FOV: 45 degrees, image size 2184x1690, CFP — 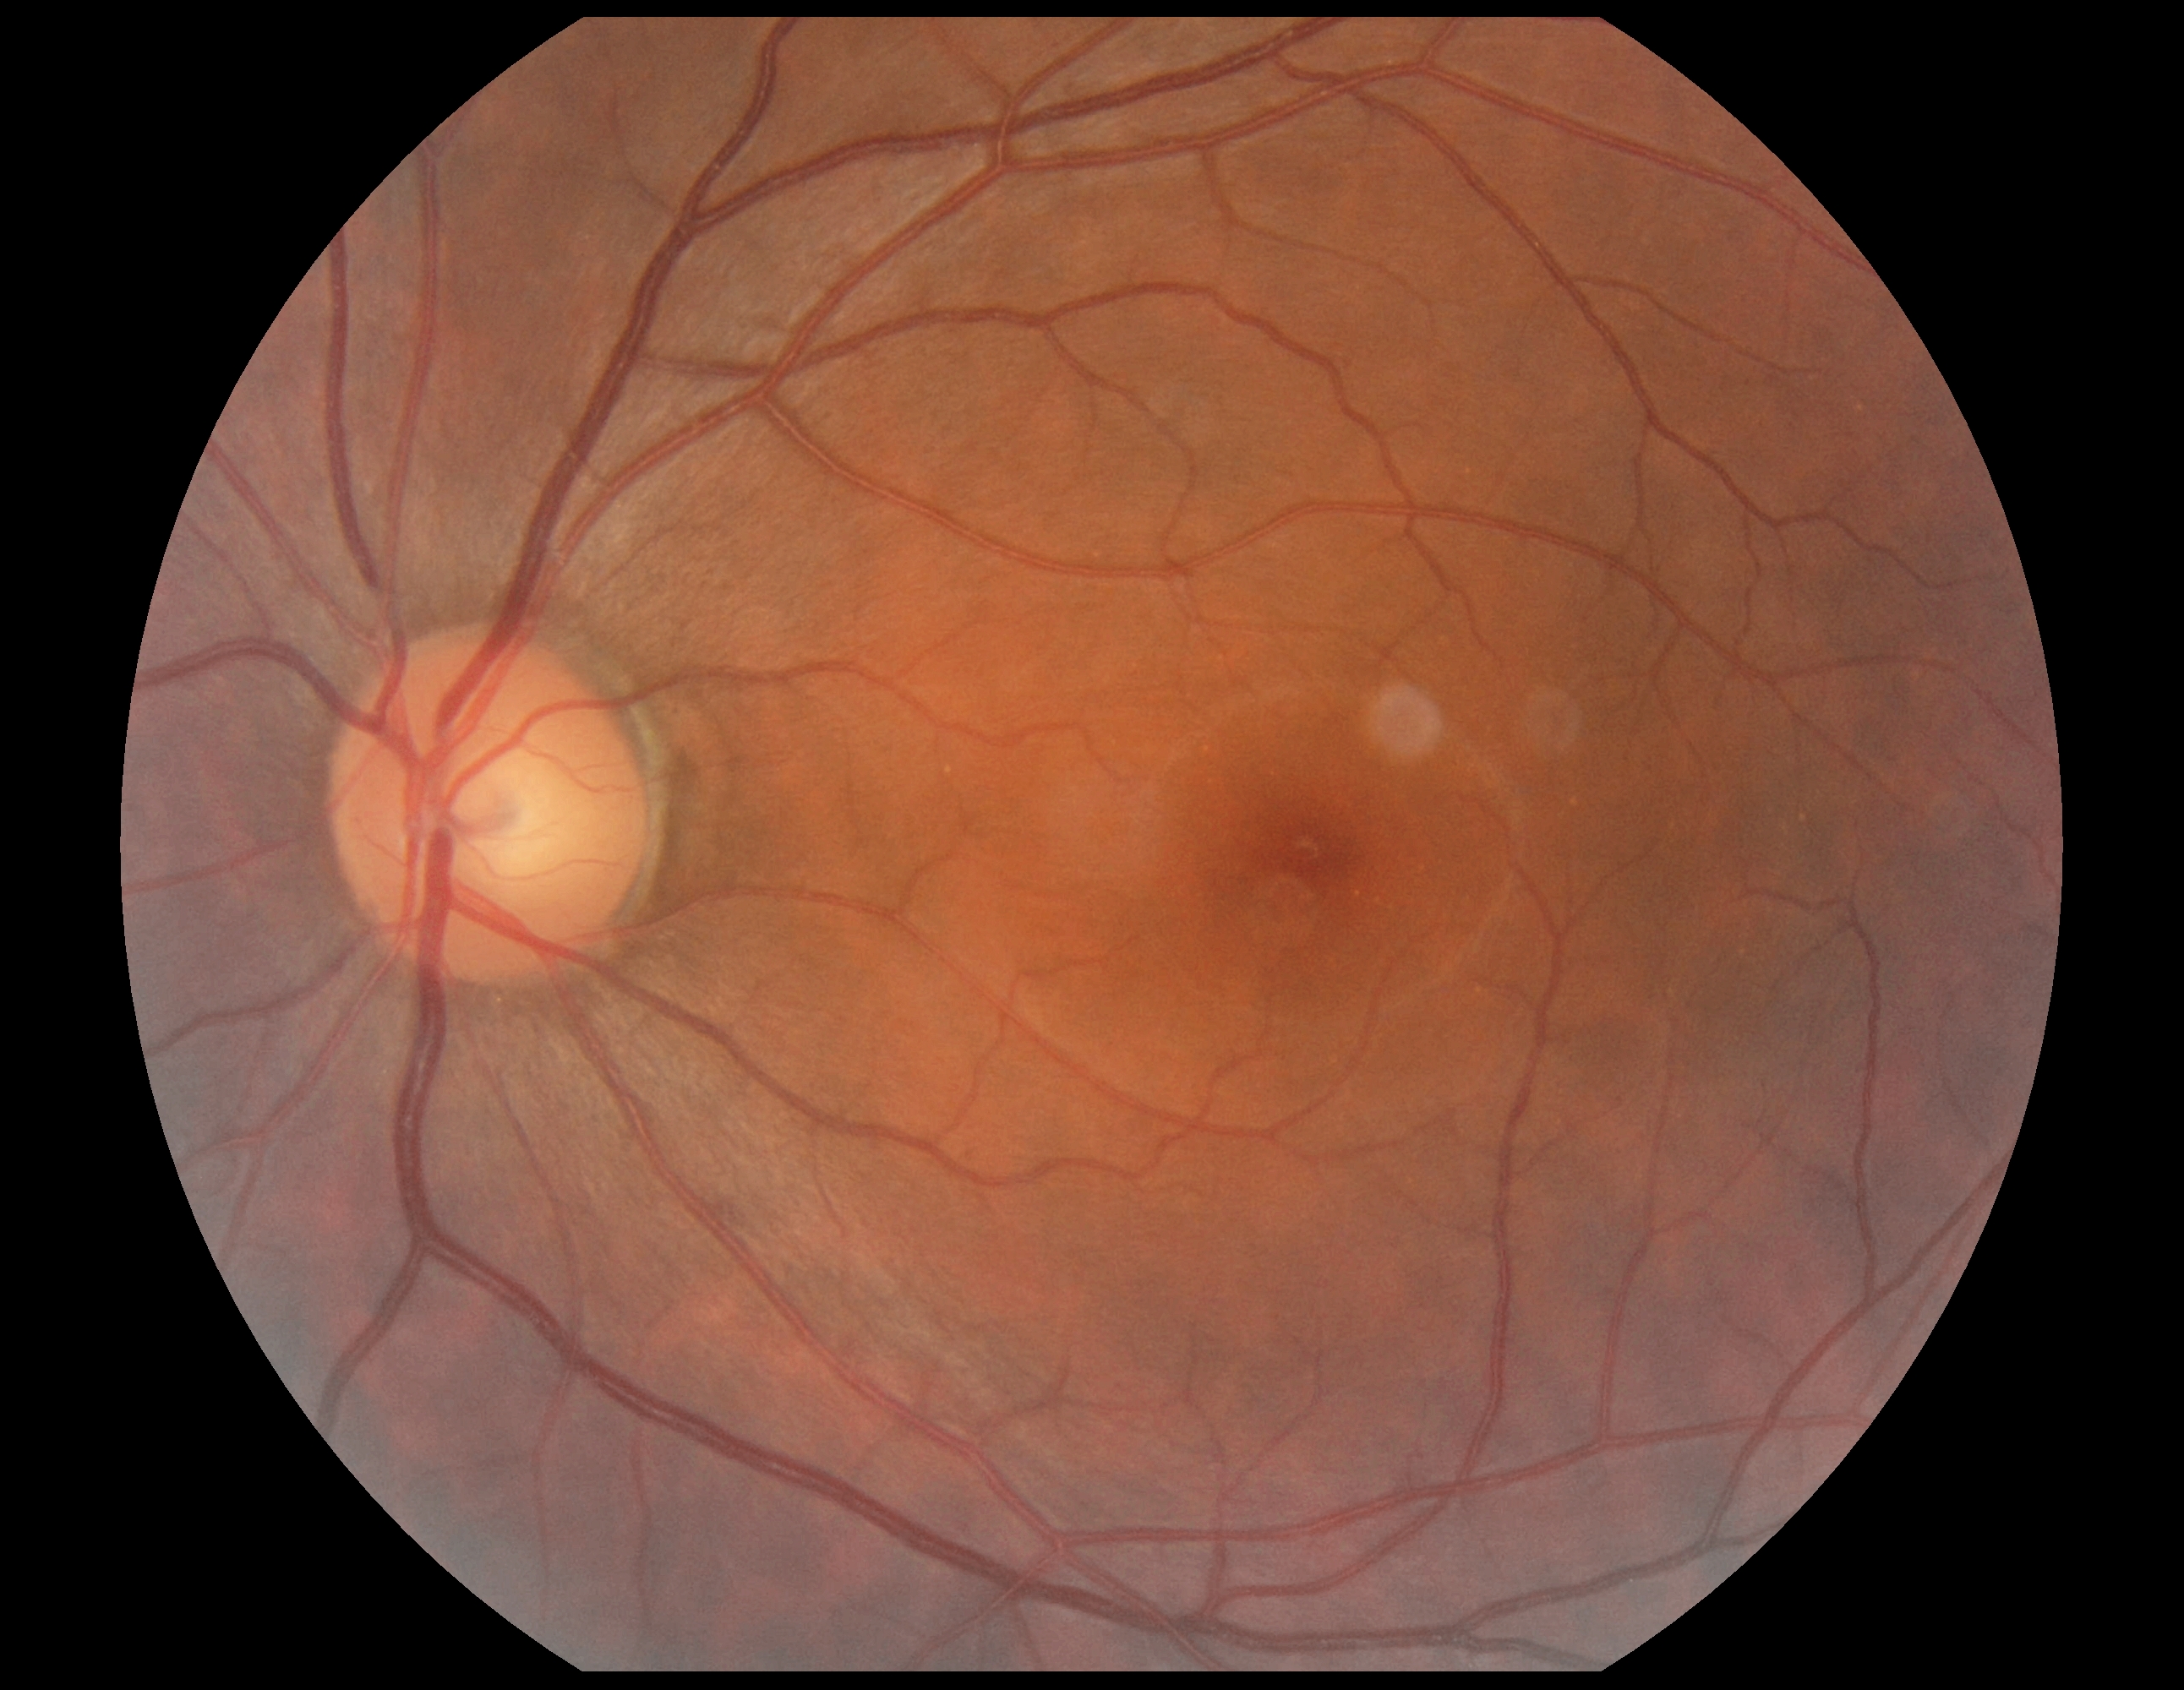

DR stage is grade 0.